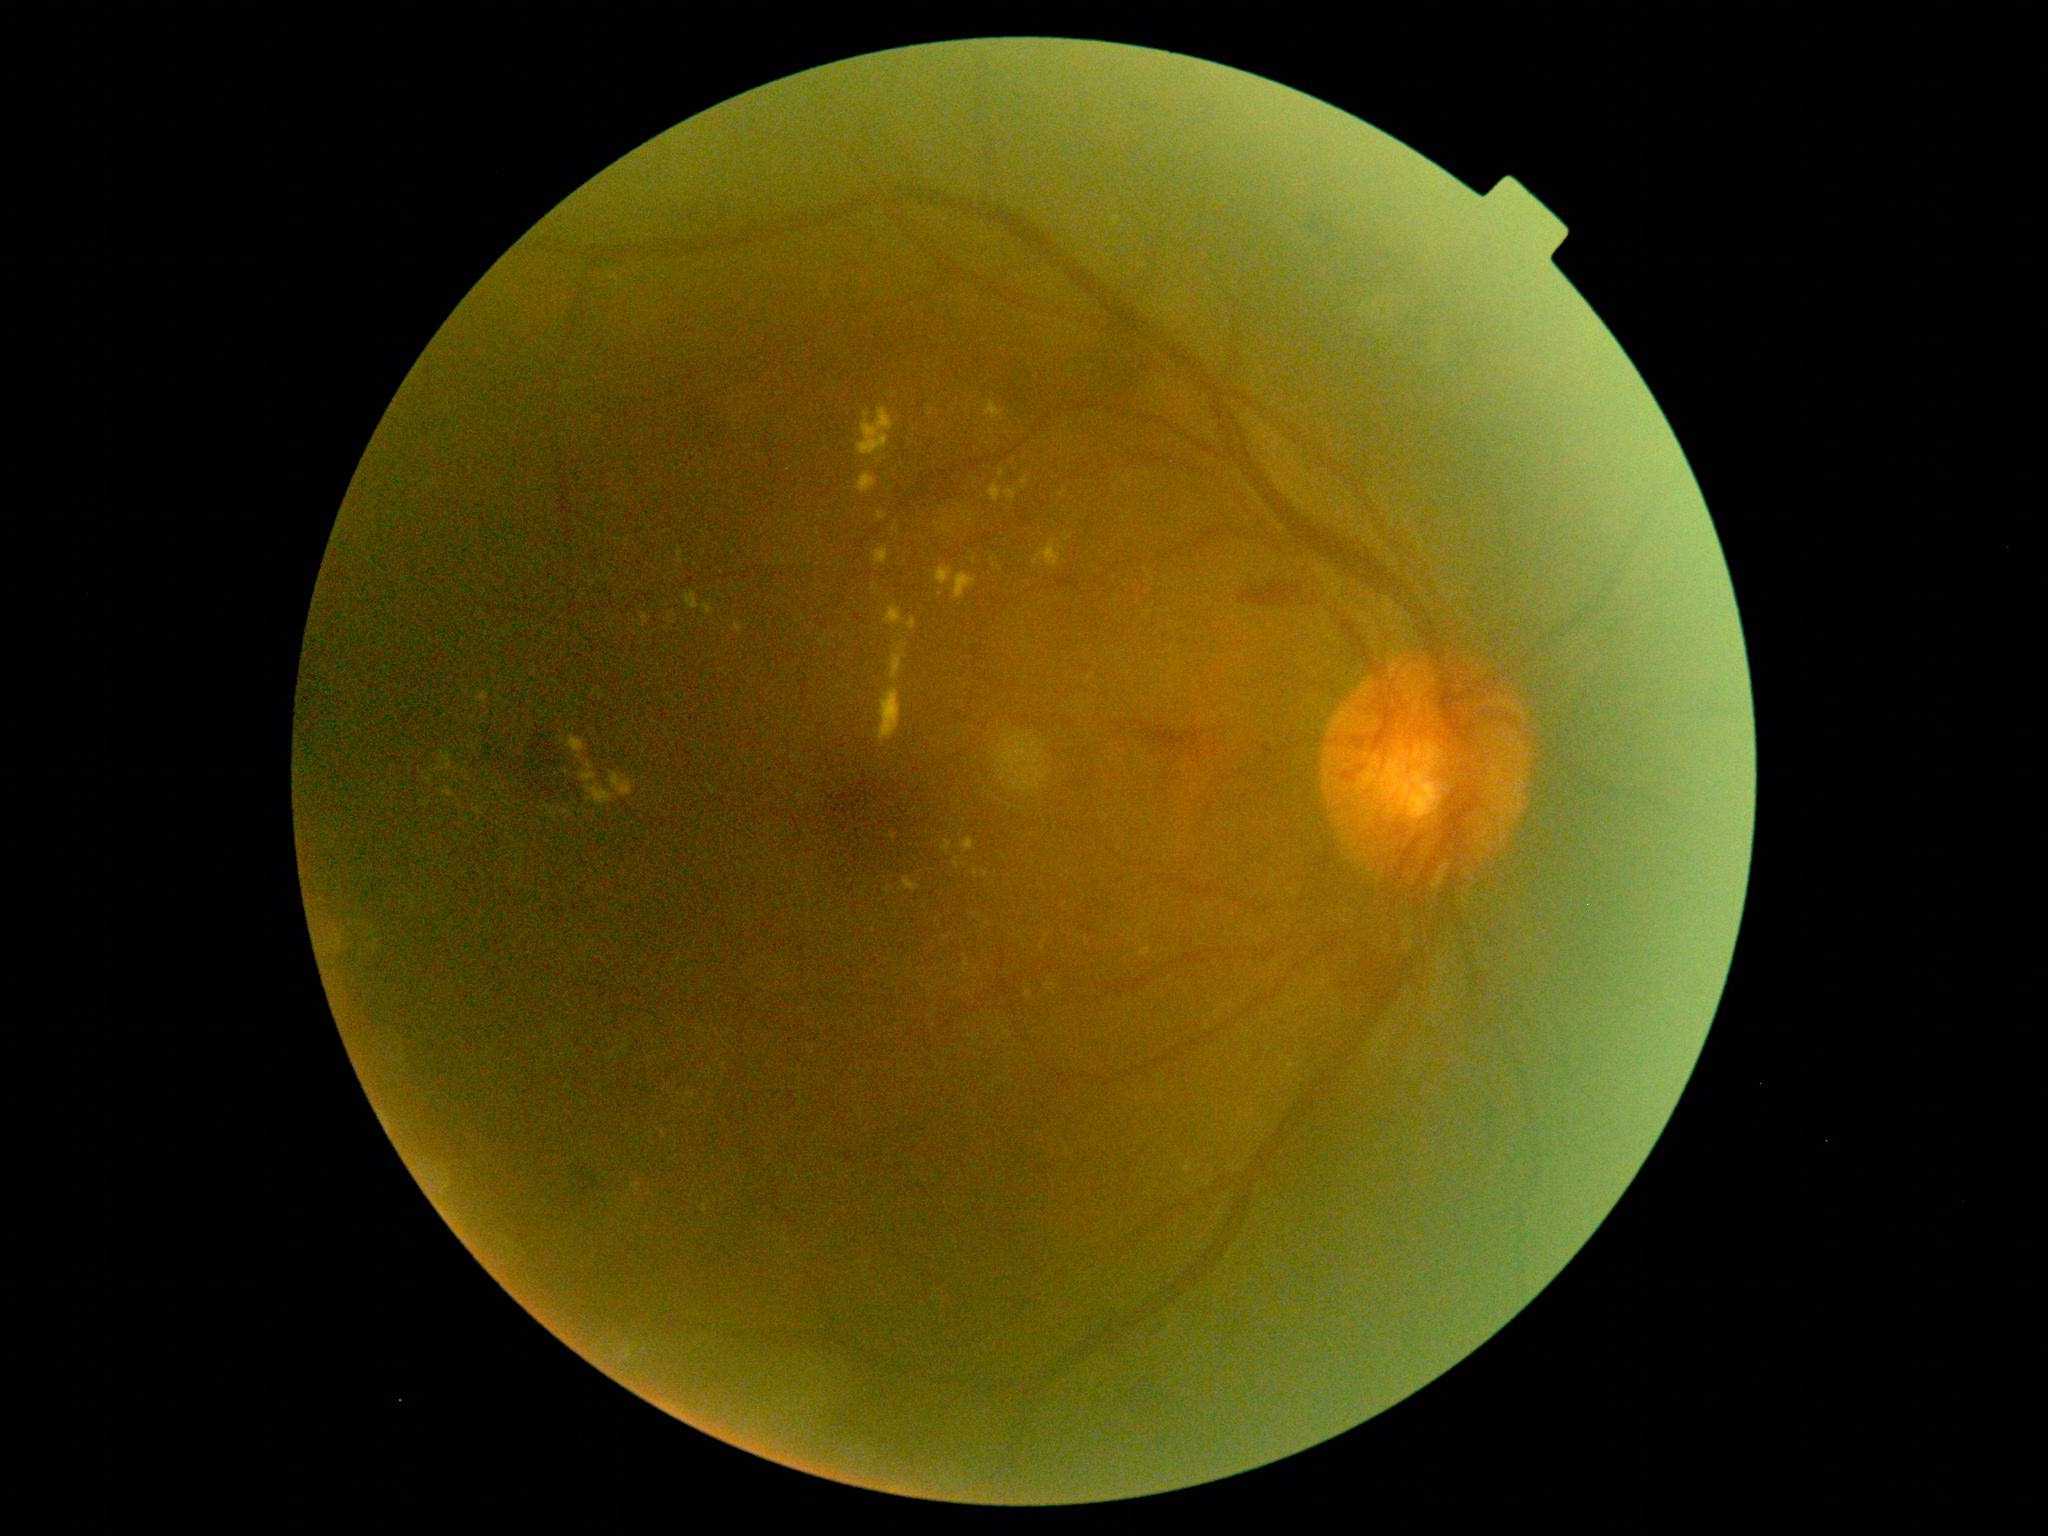 Annotations:
• DR class — proliferative diabetic retinopathy
• DR stage — PDR (grade 4)